2212x1661px. Male. Optic disc at the center of the field: 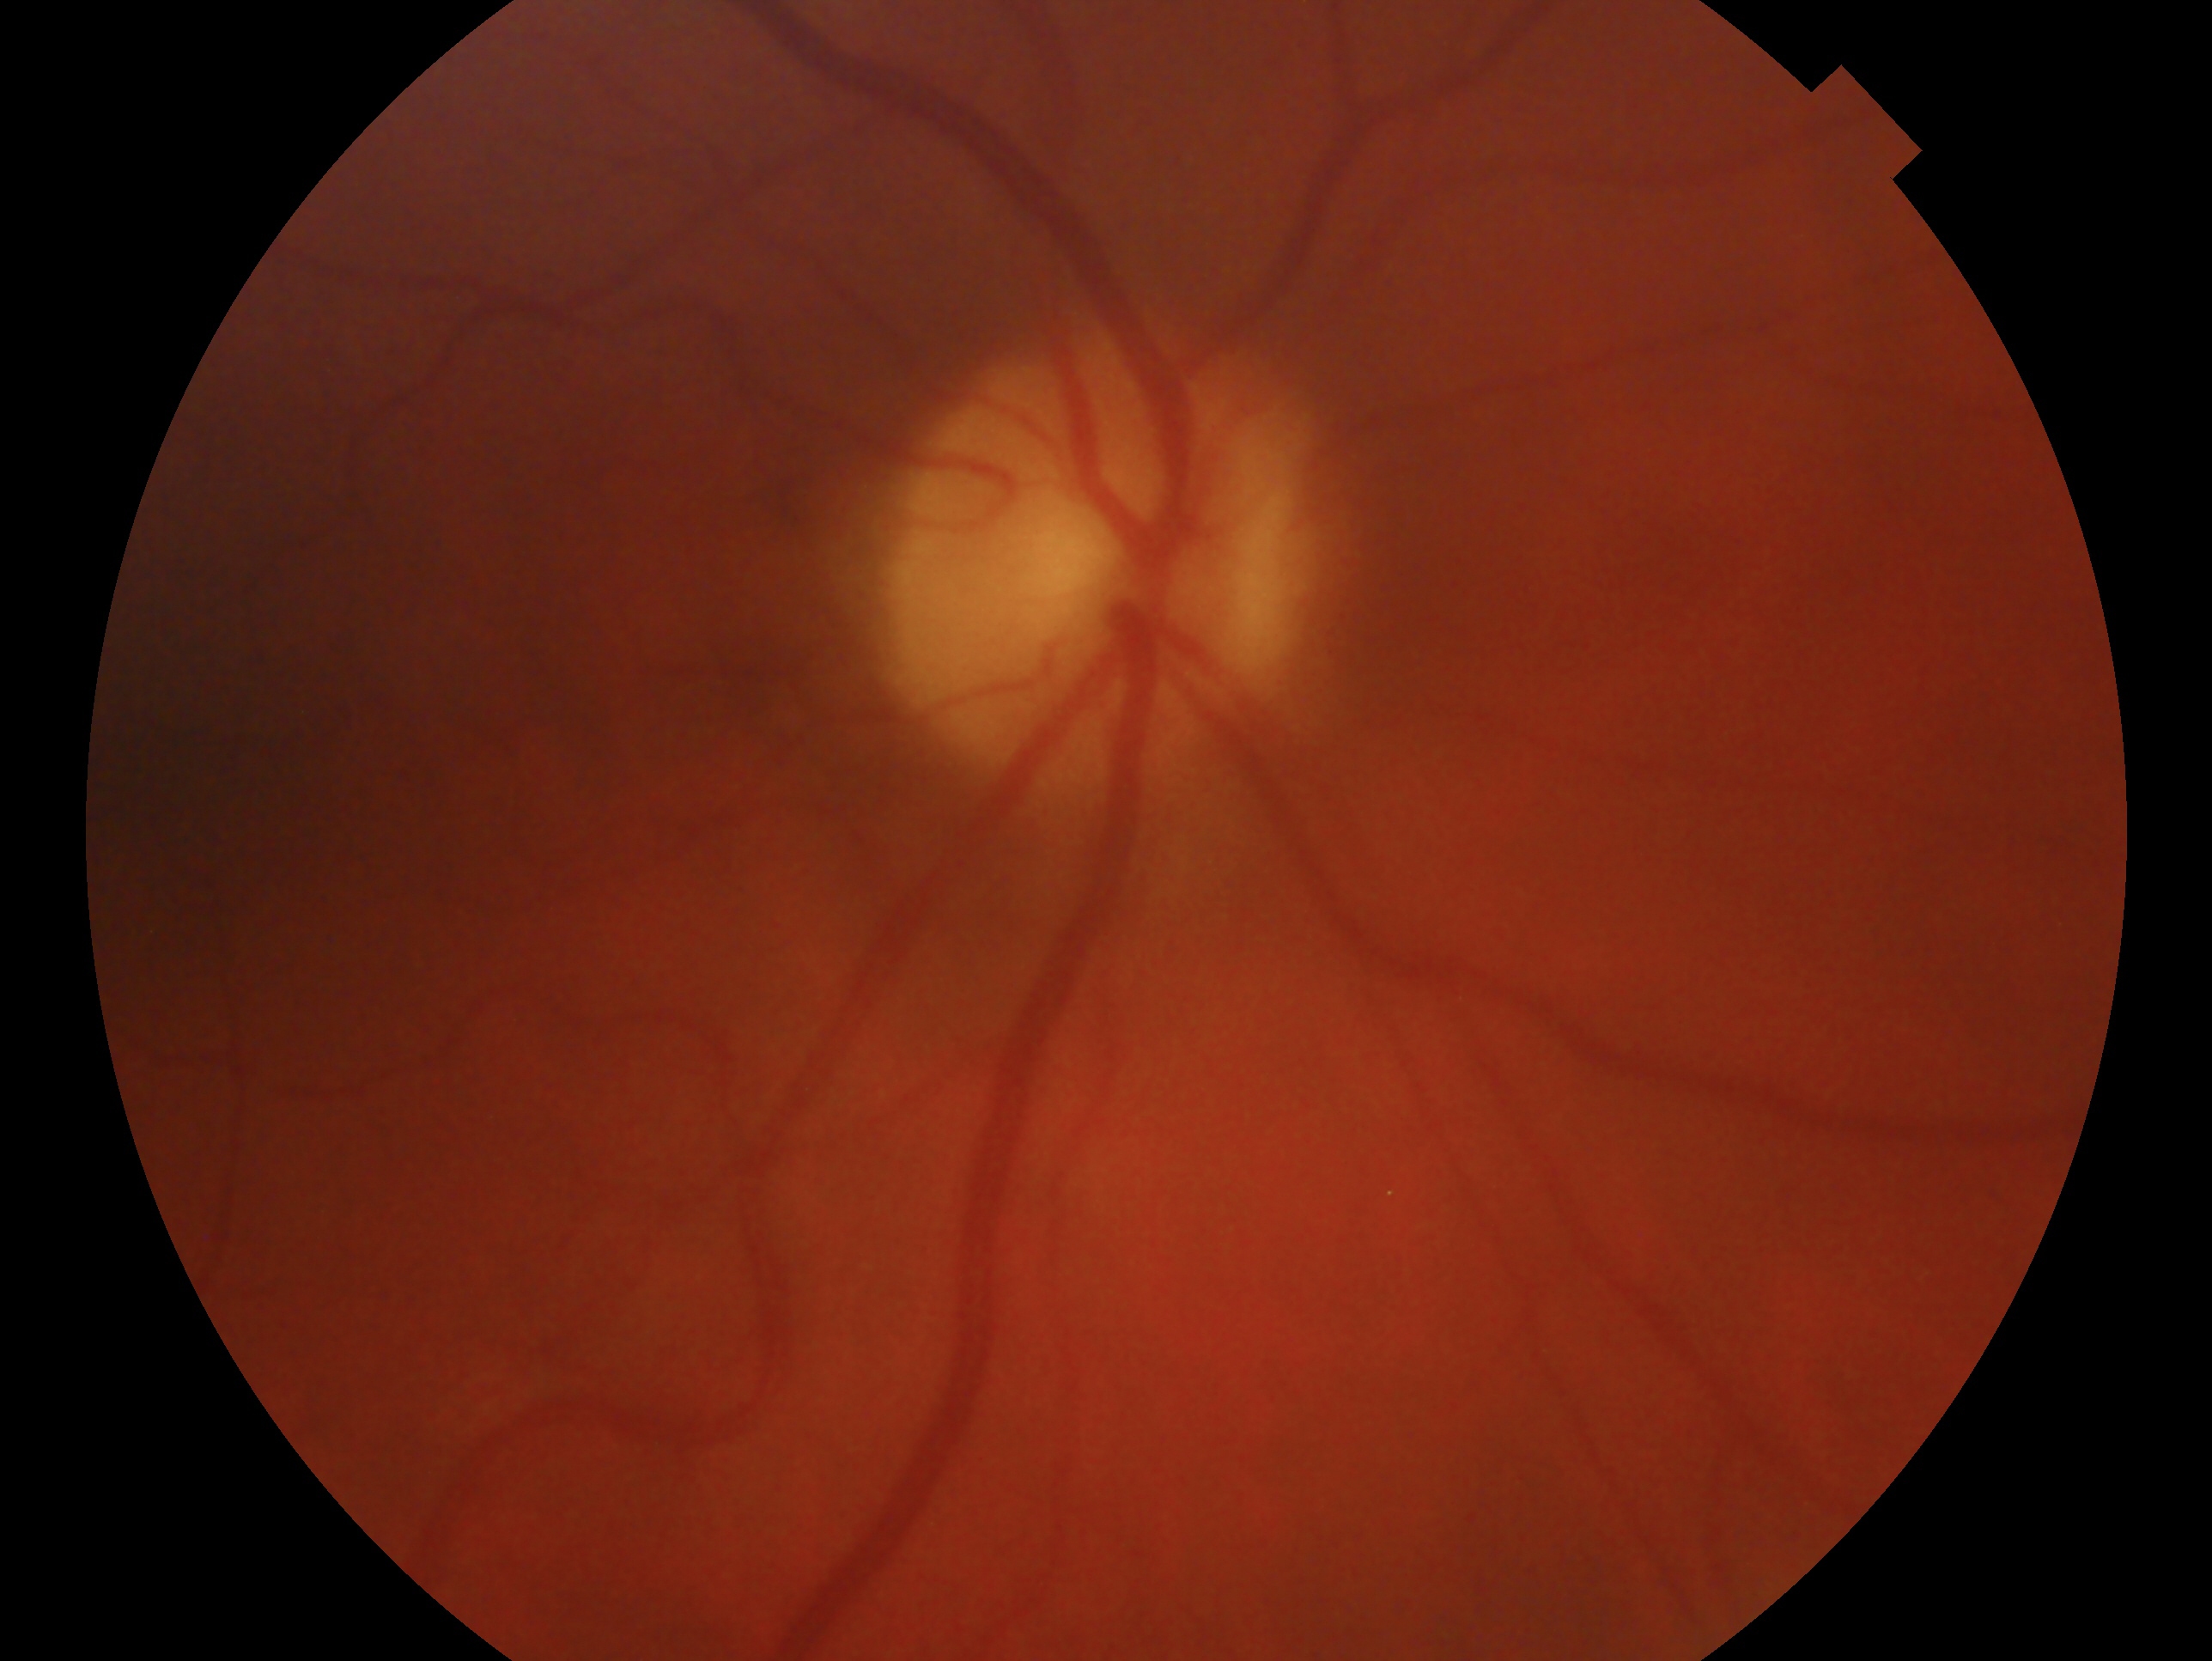 Glaucoma diagnosis: no glaucoma. Imaged eye: right.